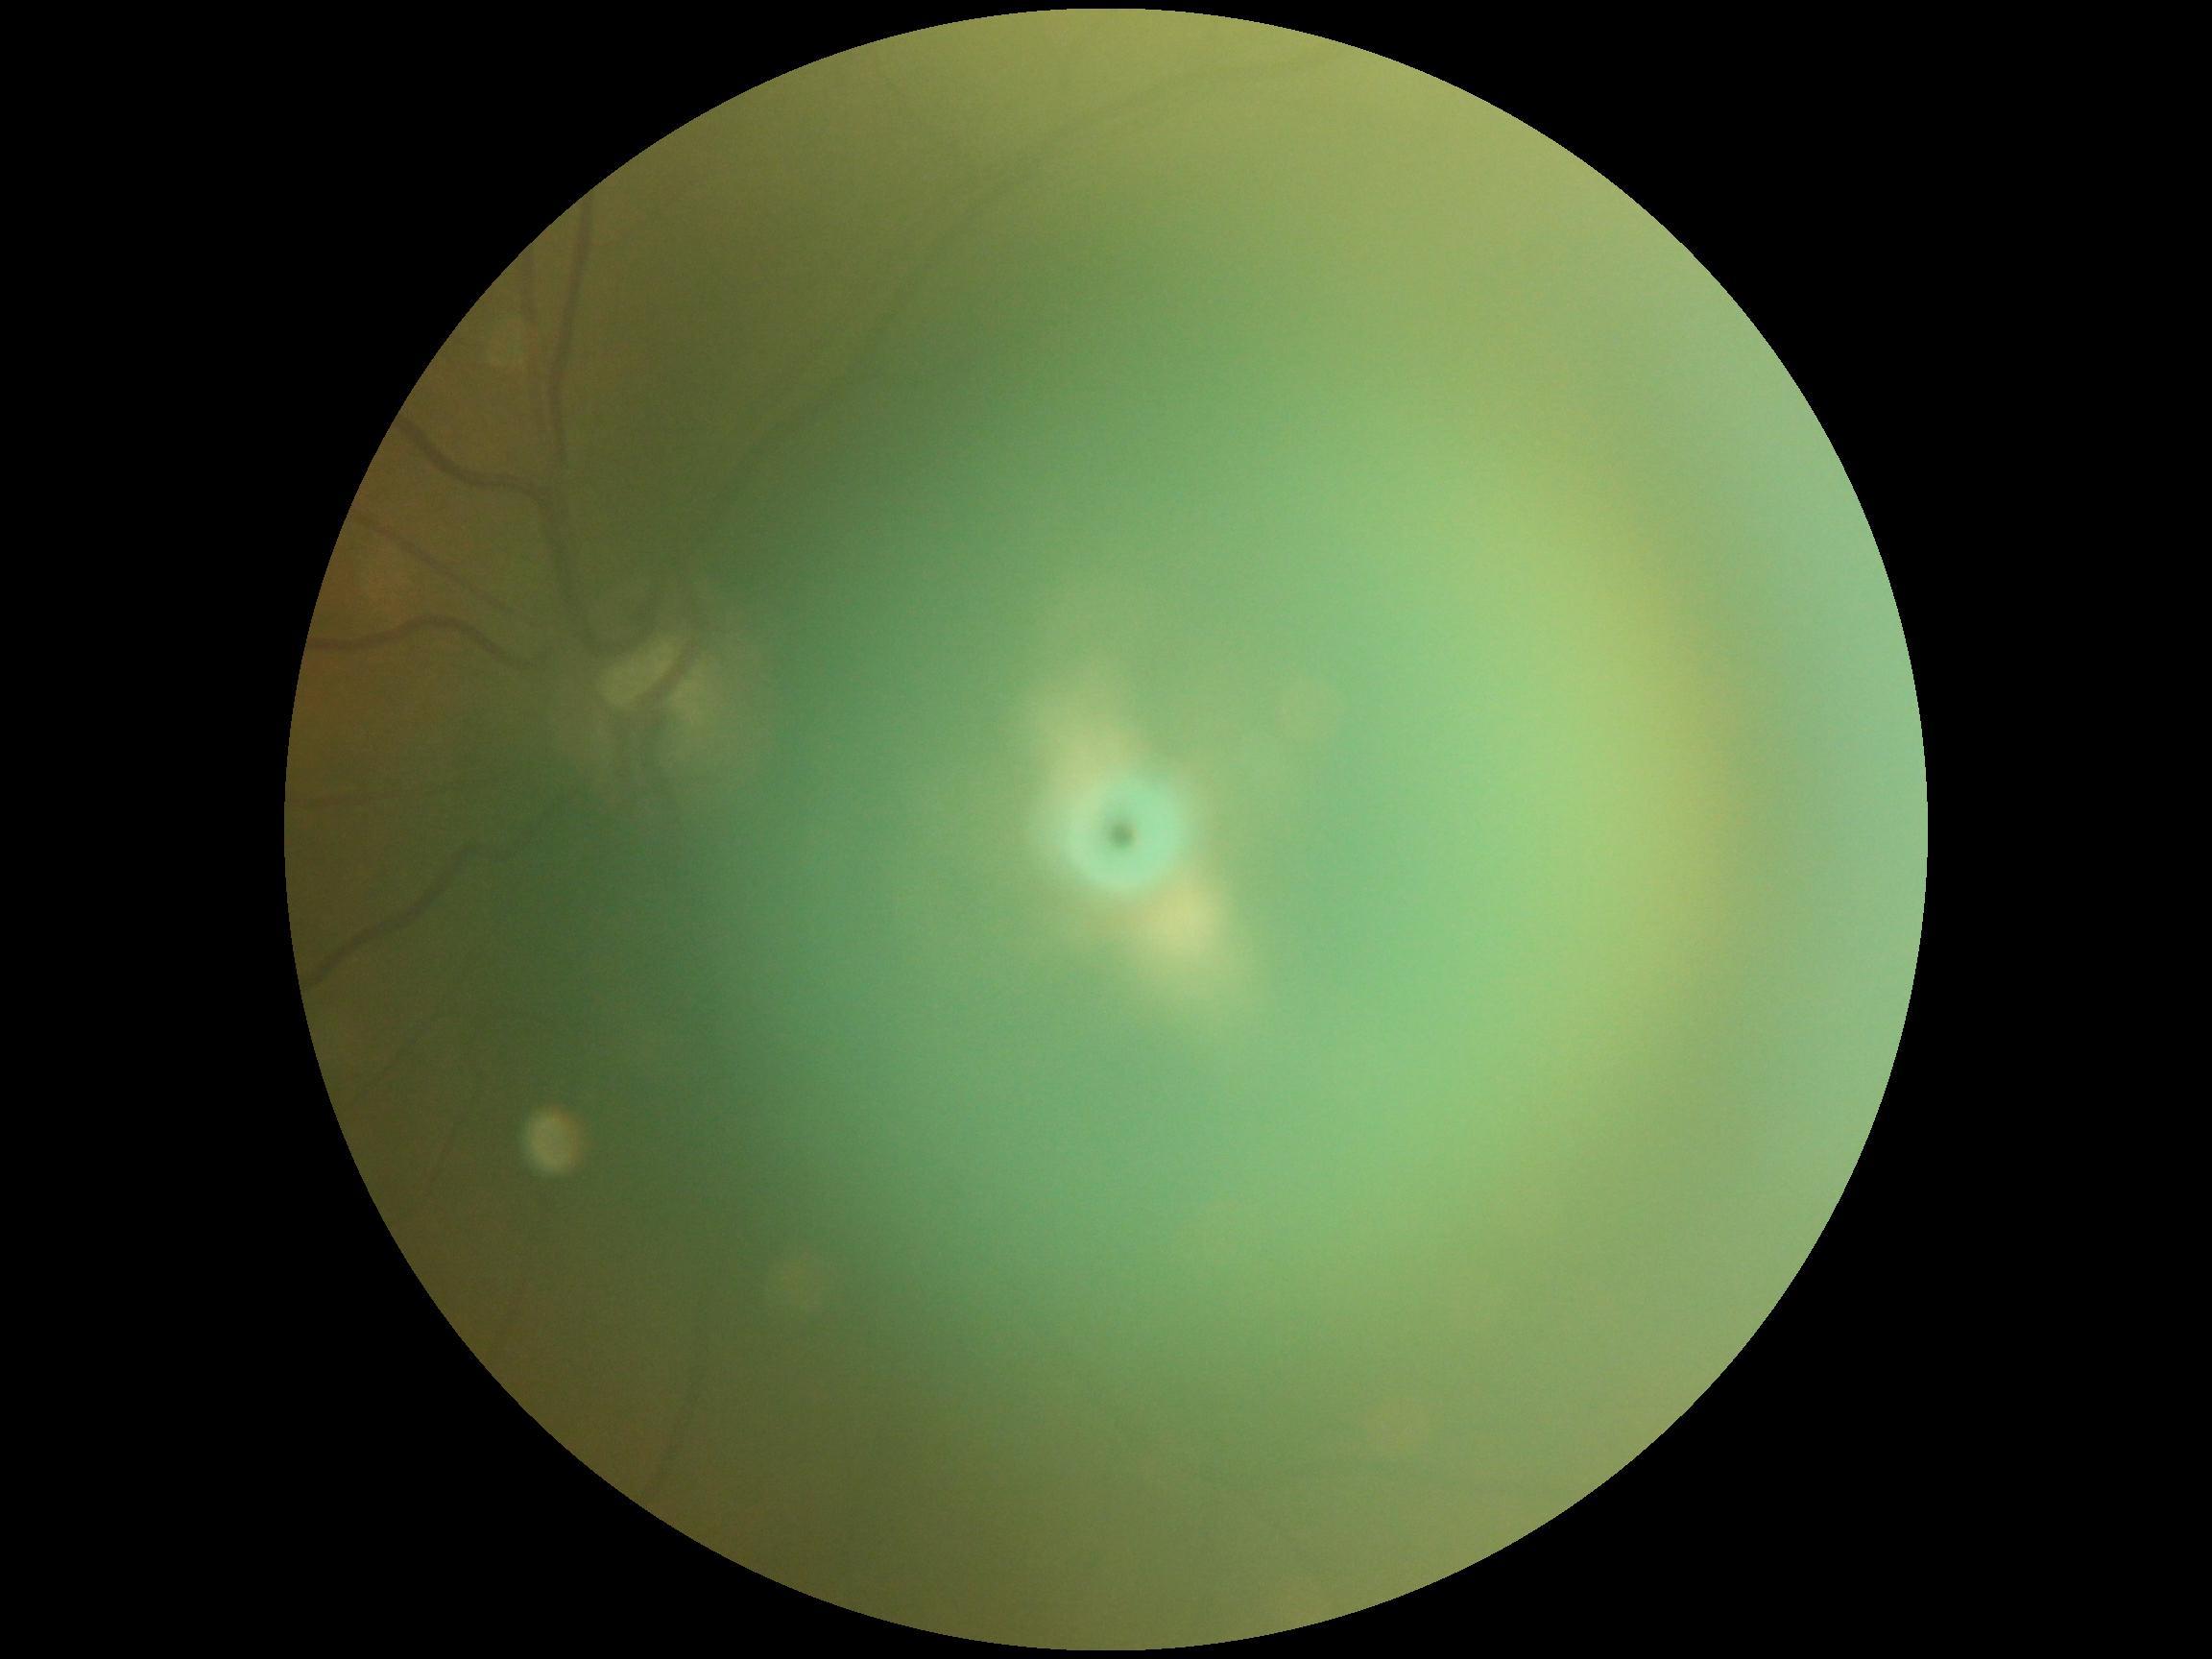

DR grade: ungradable. Quality too poor to assess for DR.